Camera: Phoenix ICON (100° FOV). Wide-field fundus image from infant ROP screening. 1240x1240
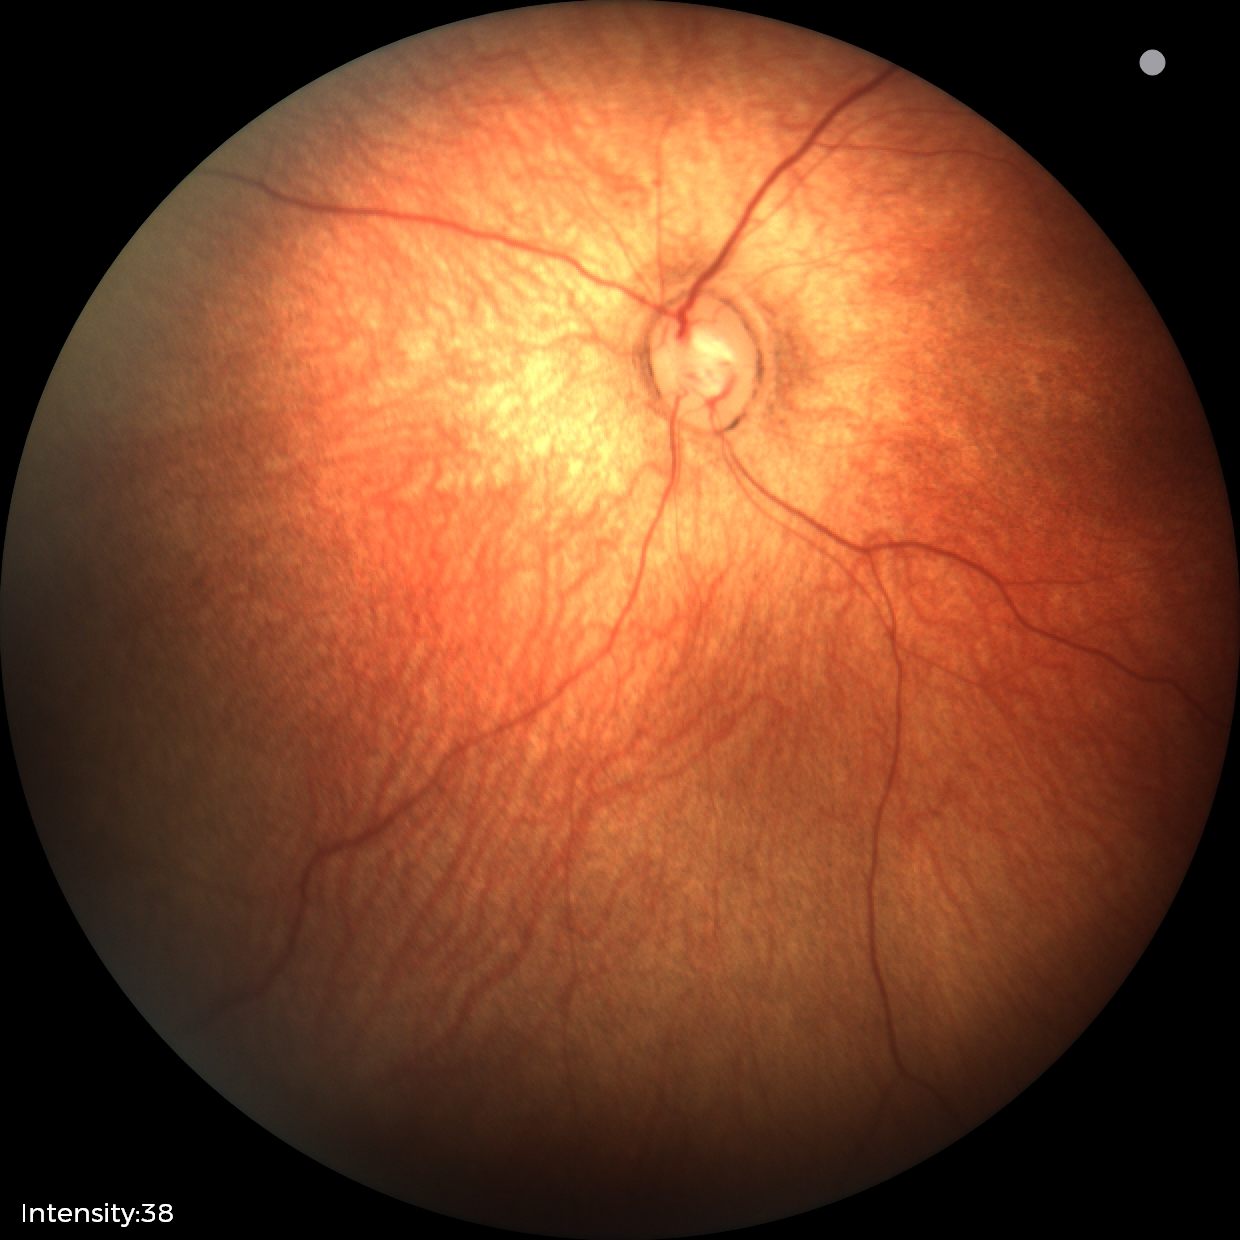
Impression: physiological appearance.